45° FOV:
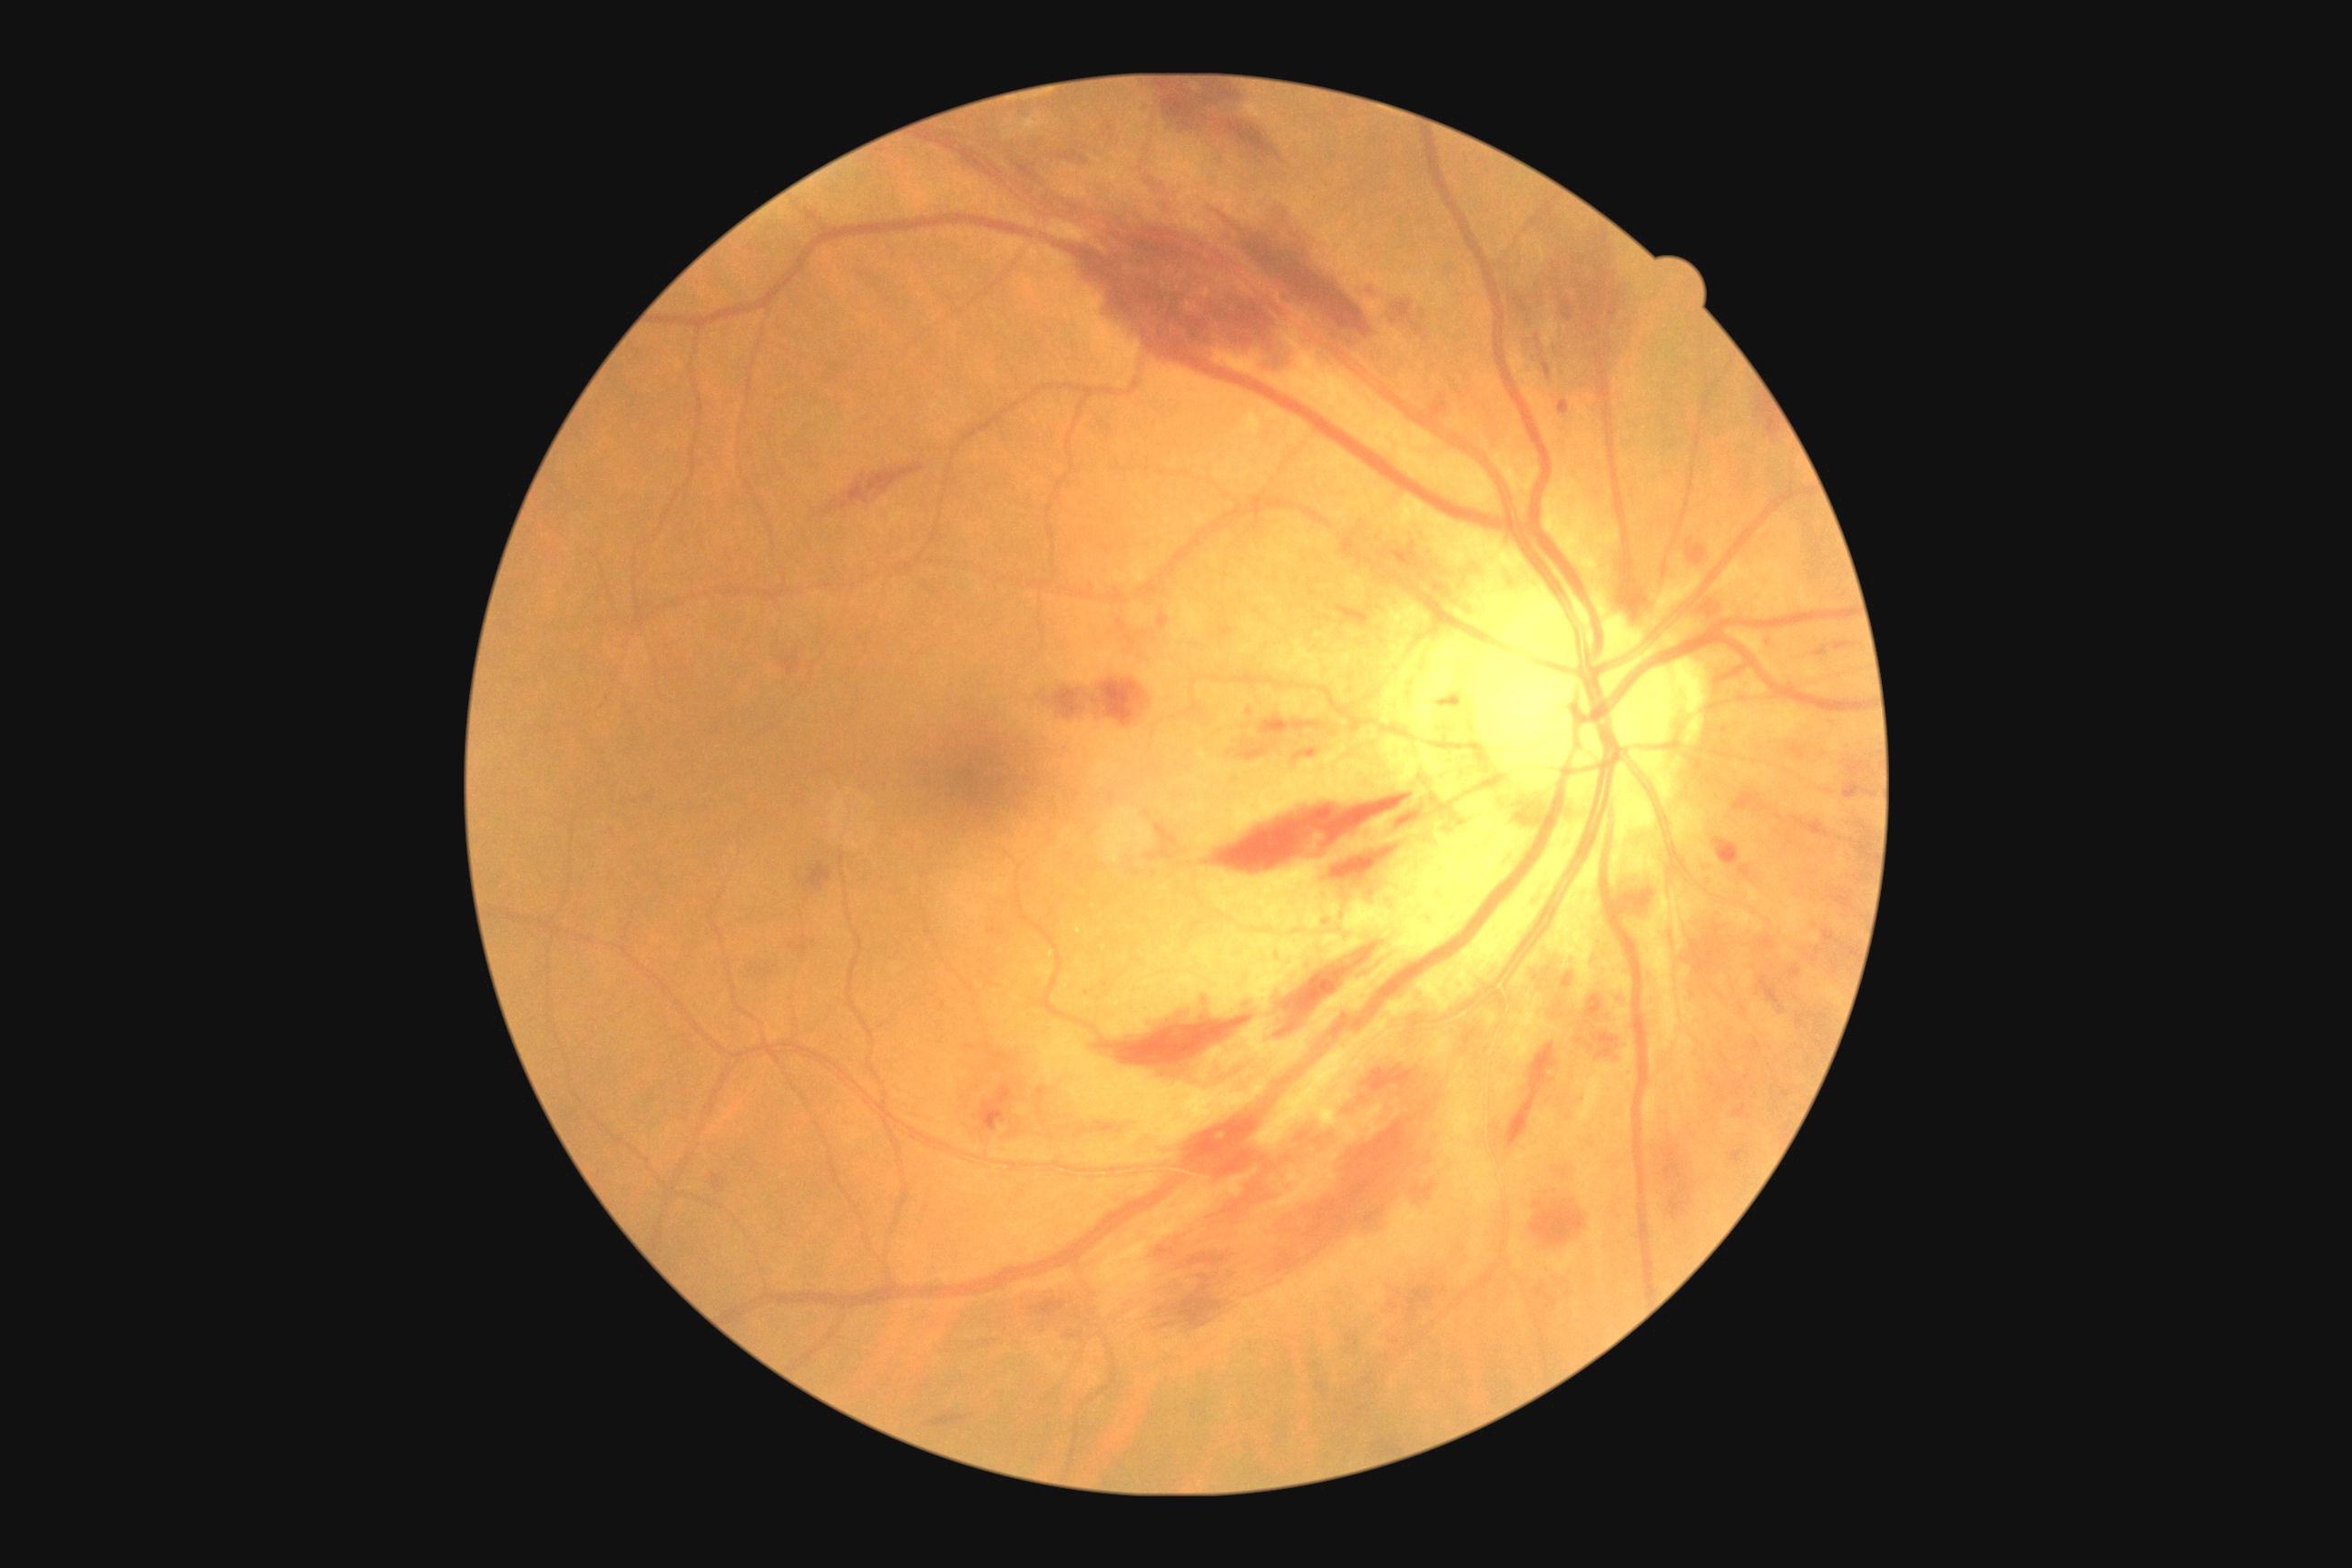 Diabetic retinopathy (DR): 2 — more than just microaneurysms but less than severe NPDR
Selected lesions:
* hemorrhages (HEs) (more not shown): bbox(1669, 1182, 1692, 1220), bbox(1226, 745, 1273, 761), bbox(1592, 1034, 1618, 1044), bbox(1720, 841, 1740, 865), bbox(1329, 836, 1406, 876), bbox(1727, 1144, 1750, 1166), bbox(1511, 286, 1533, 317), bbox(1386, 299, 1426, 340), bbox(1740, 865, 1750, 877), bbox(1358, 1095, 1366, 1104), bbox(1389, 1291, 1400, 1313), bbox(1607, 280, 1616, 324), bbox(1159, 614, 1170, 629), bbox(1152, 1233, 1199, 1257), bbox(1093, 994, 1255, 1066), bbox(1346, 1333, 1358, 1349), bbox(1070, 233, 1300, 373)